848x848px; camera: NIDEK AFC-230: 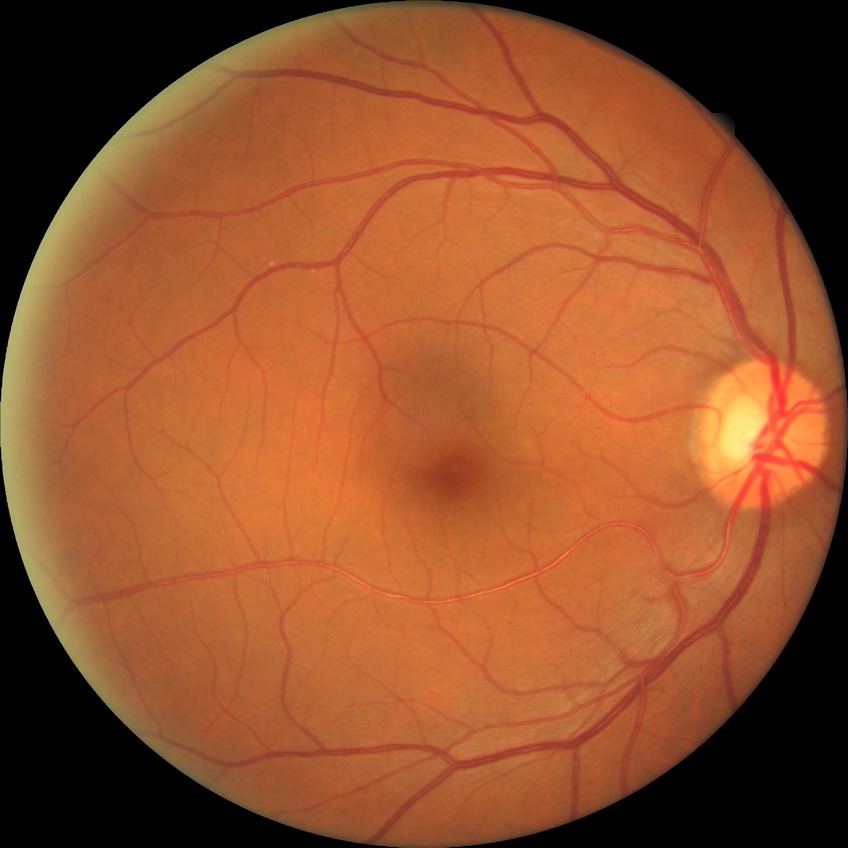

Retinopathy grade is no diabetic retinopathy.